Davis DR grading.
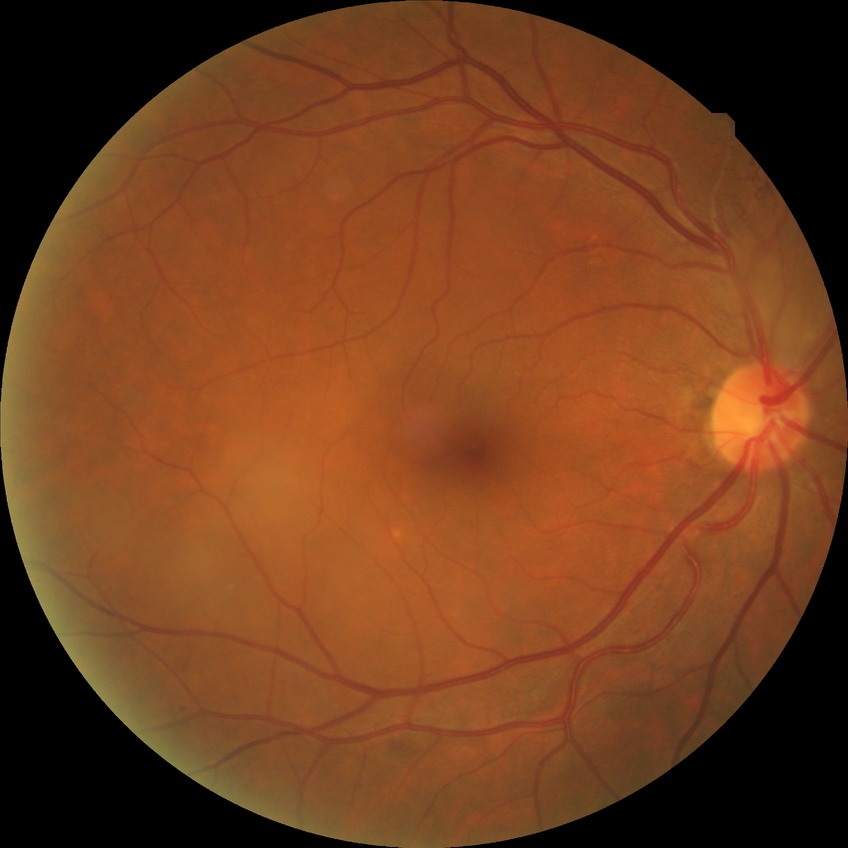 Diabetic retinopathy (DR) is simple diabetic retinopathy (SDR).